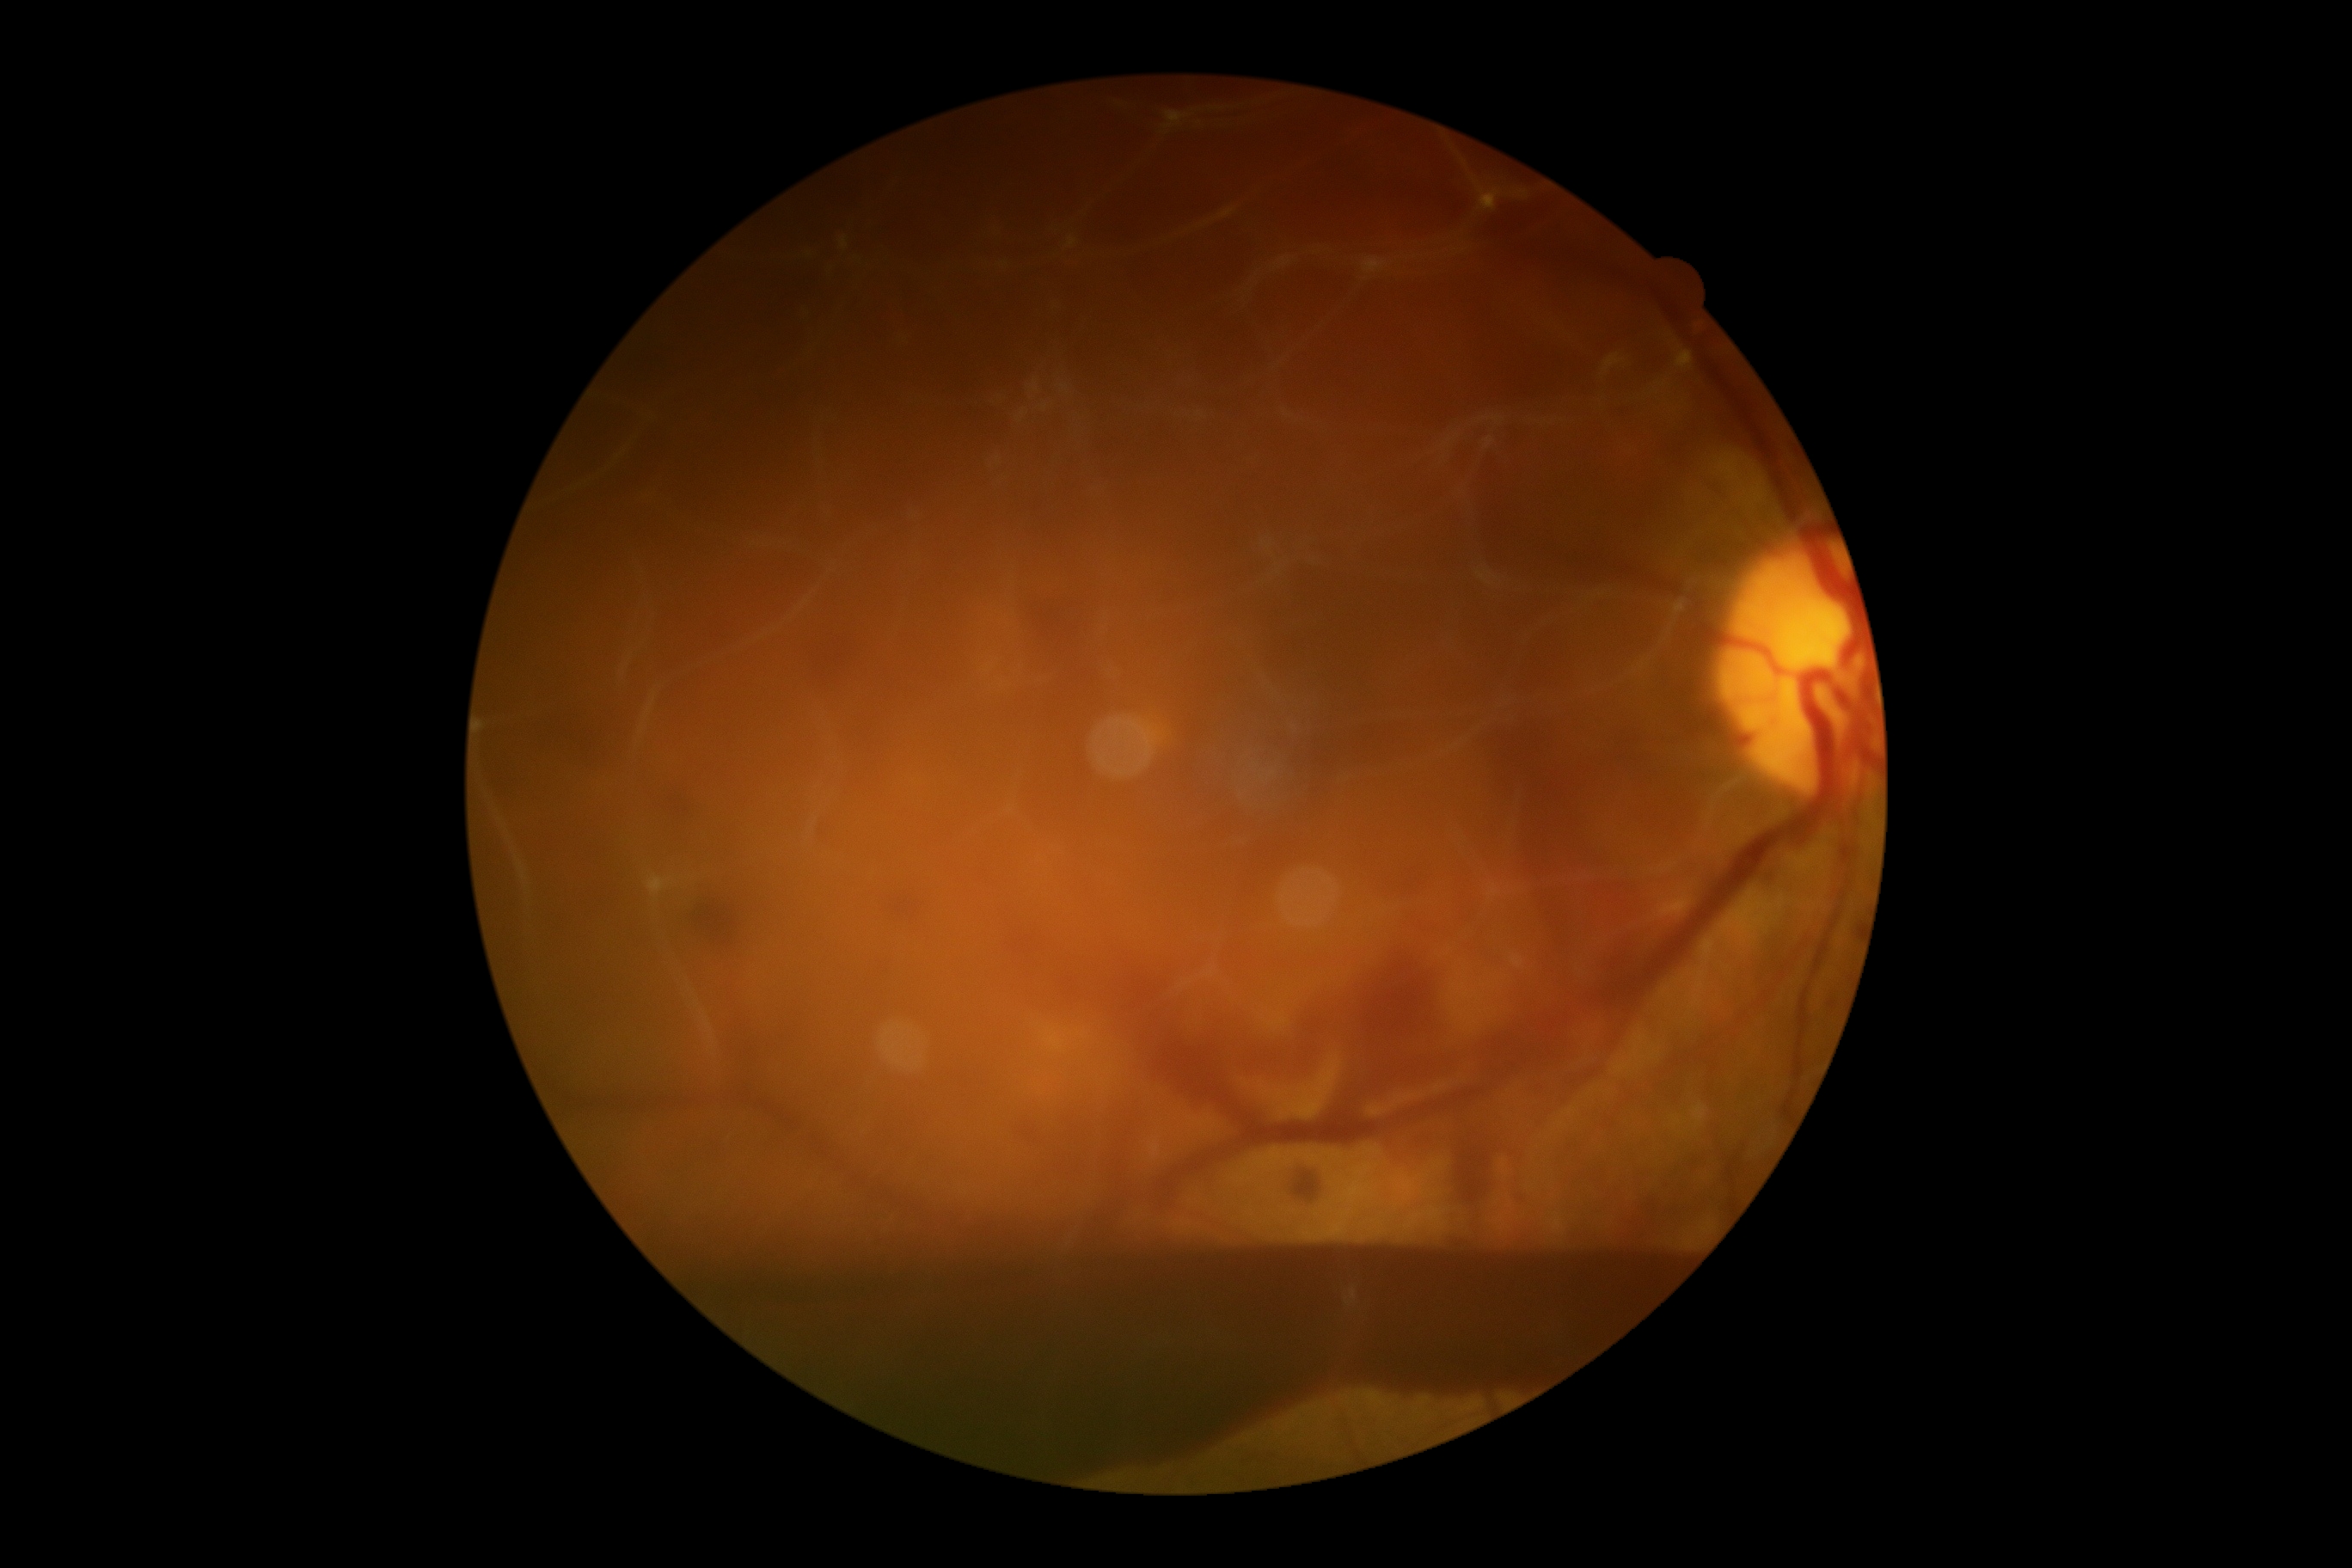 DR grade = 4; DR class = proliferative diabetic retinopathy.